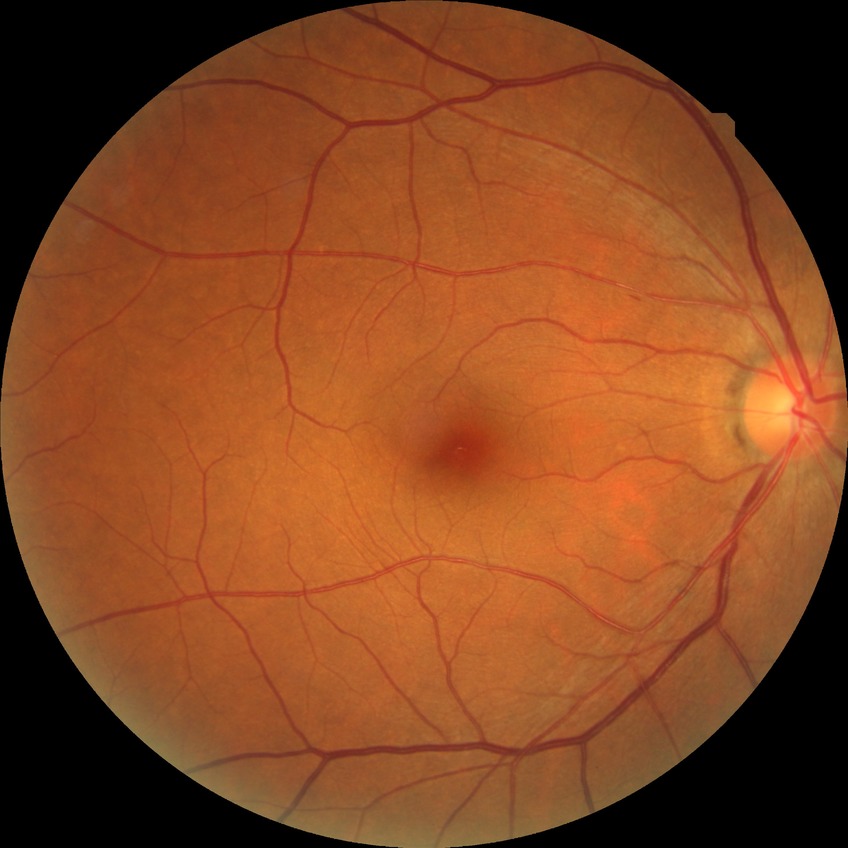 DR grade: NDR.